Color fundus photograph.
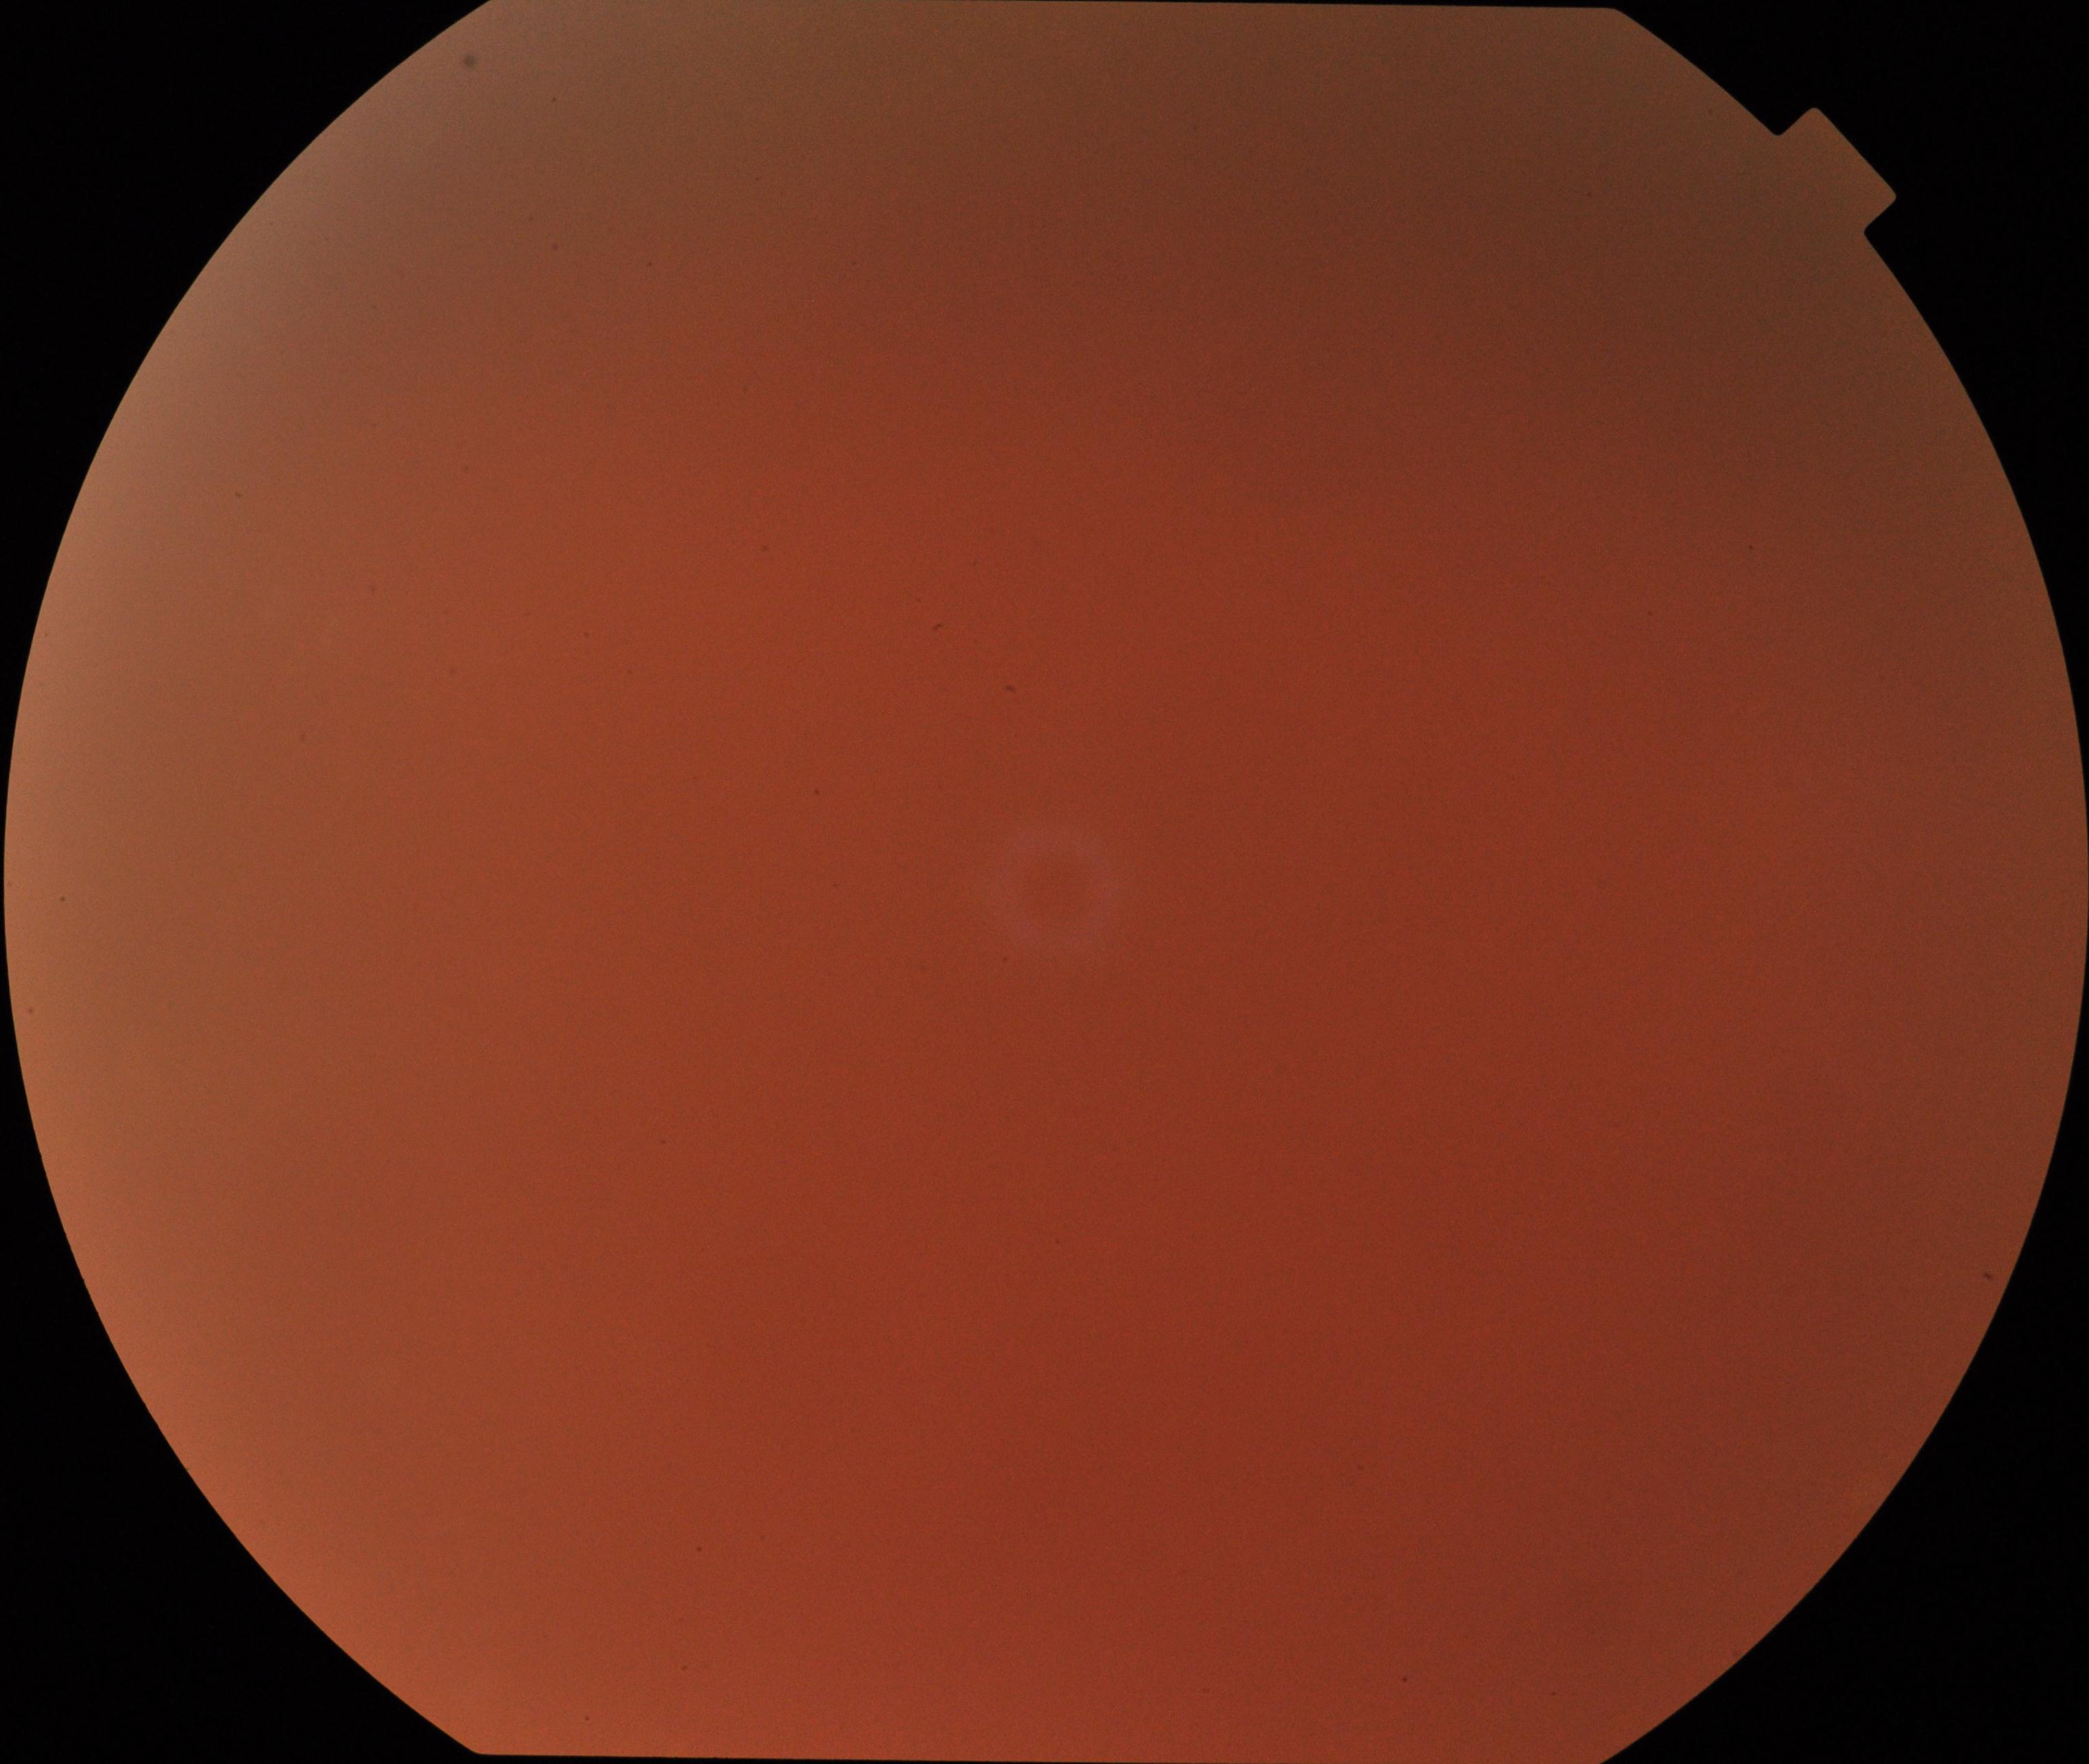
Quality: poor.
Proliferative diabetic retinopathy: negative.